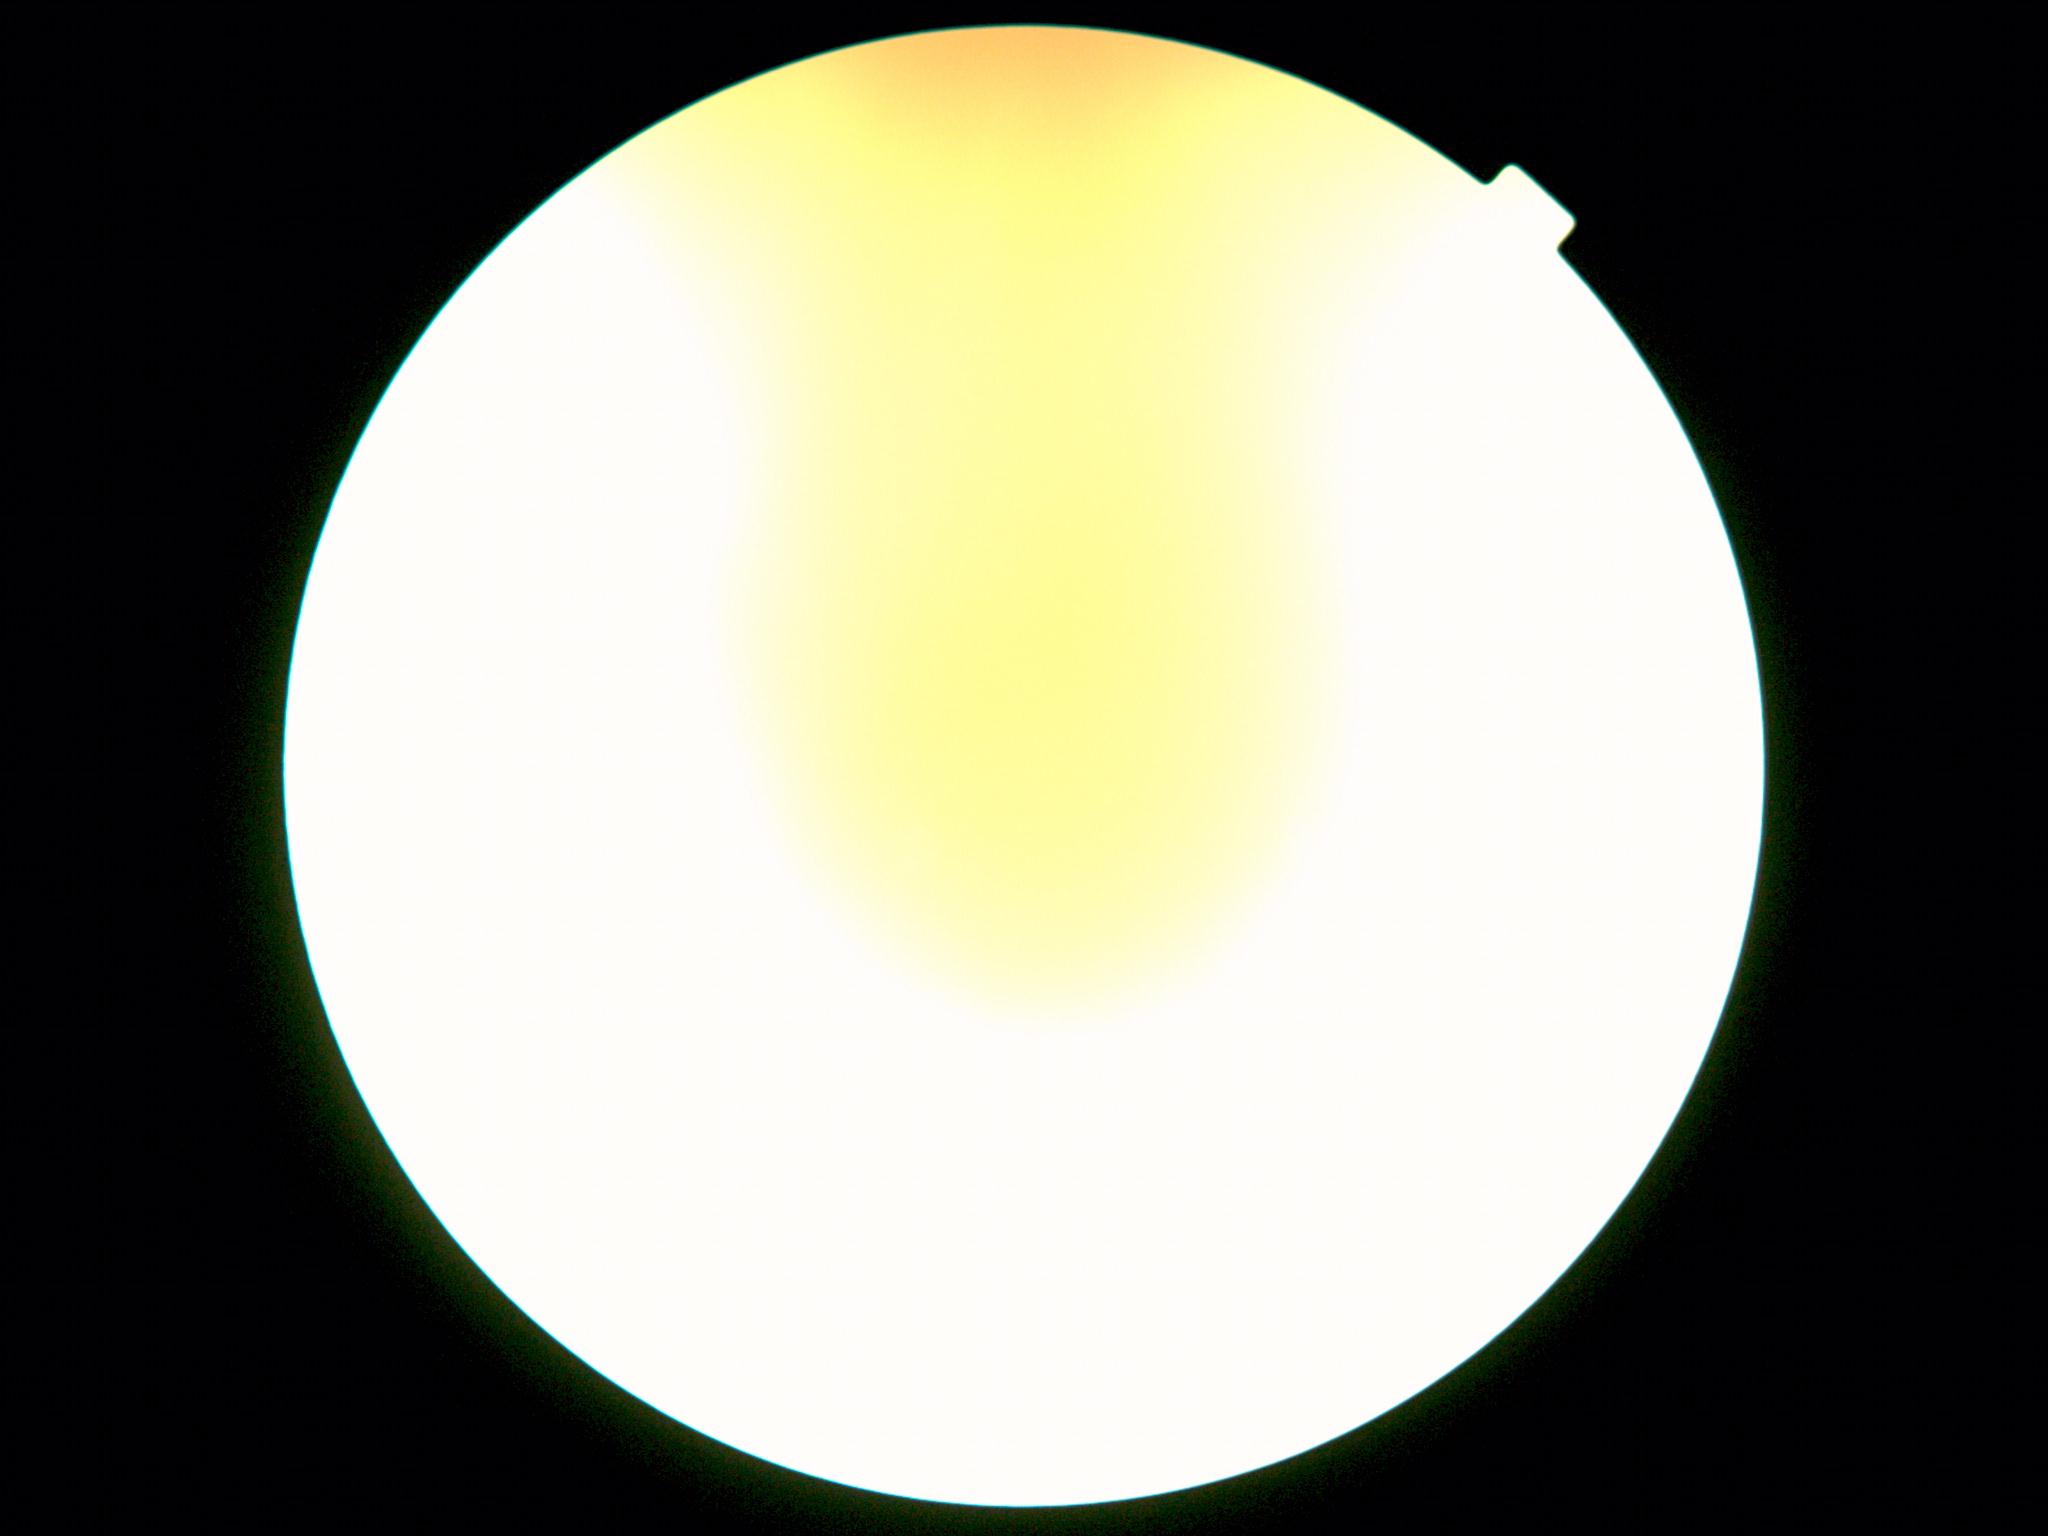

Diabetic retinopathy grade is ungradable.
Quality too poor to assess for DR.